50° field of view; 1534 by 1534 pixels
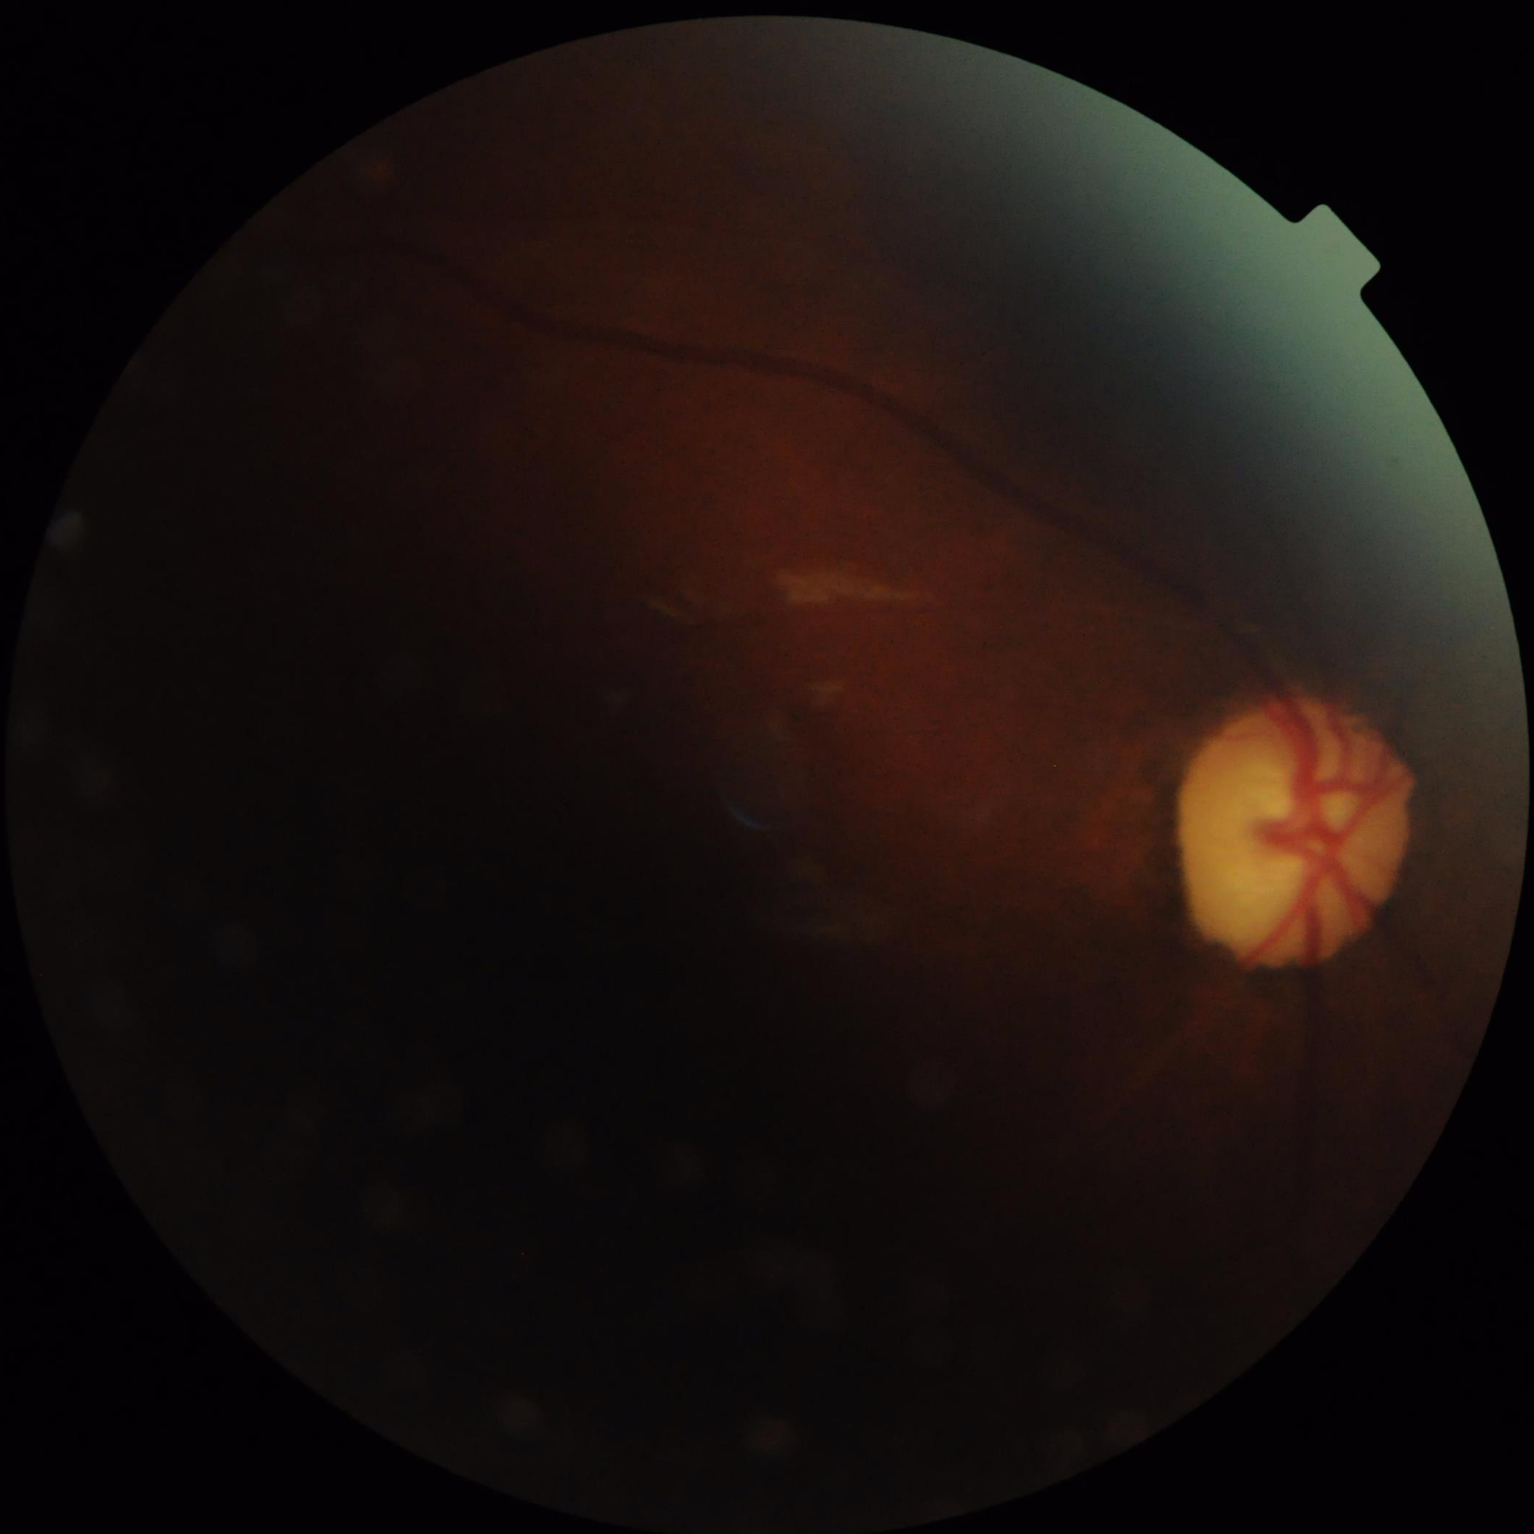

Overall image quality = poor, ungradable
Contrast = narrow intensity range, structures hard to distinguish
Illumination = inadequate, with uneven exposure or color distortion
Clarity = reduced sharpness with visible blur